Fundus photo: 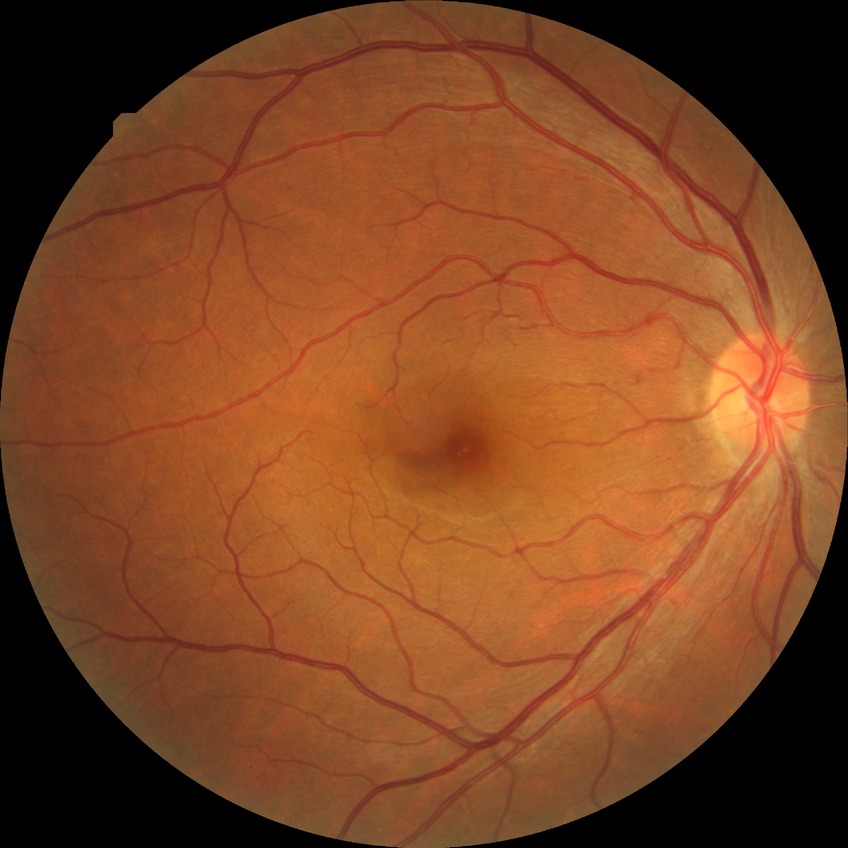

diabetic retinopathy (DR): no diabetic retinopathy (NDR).